45° field of view.
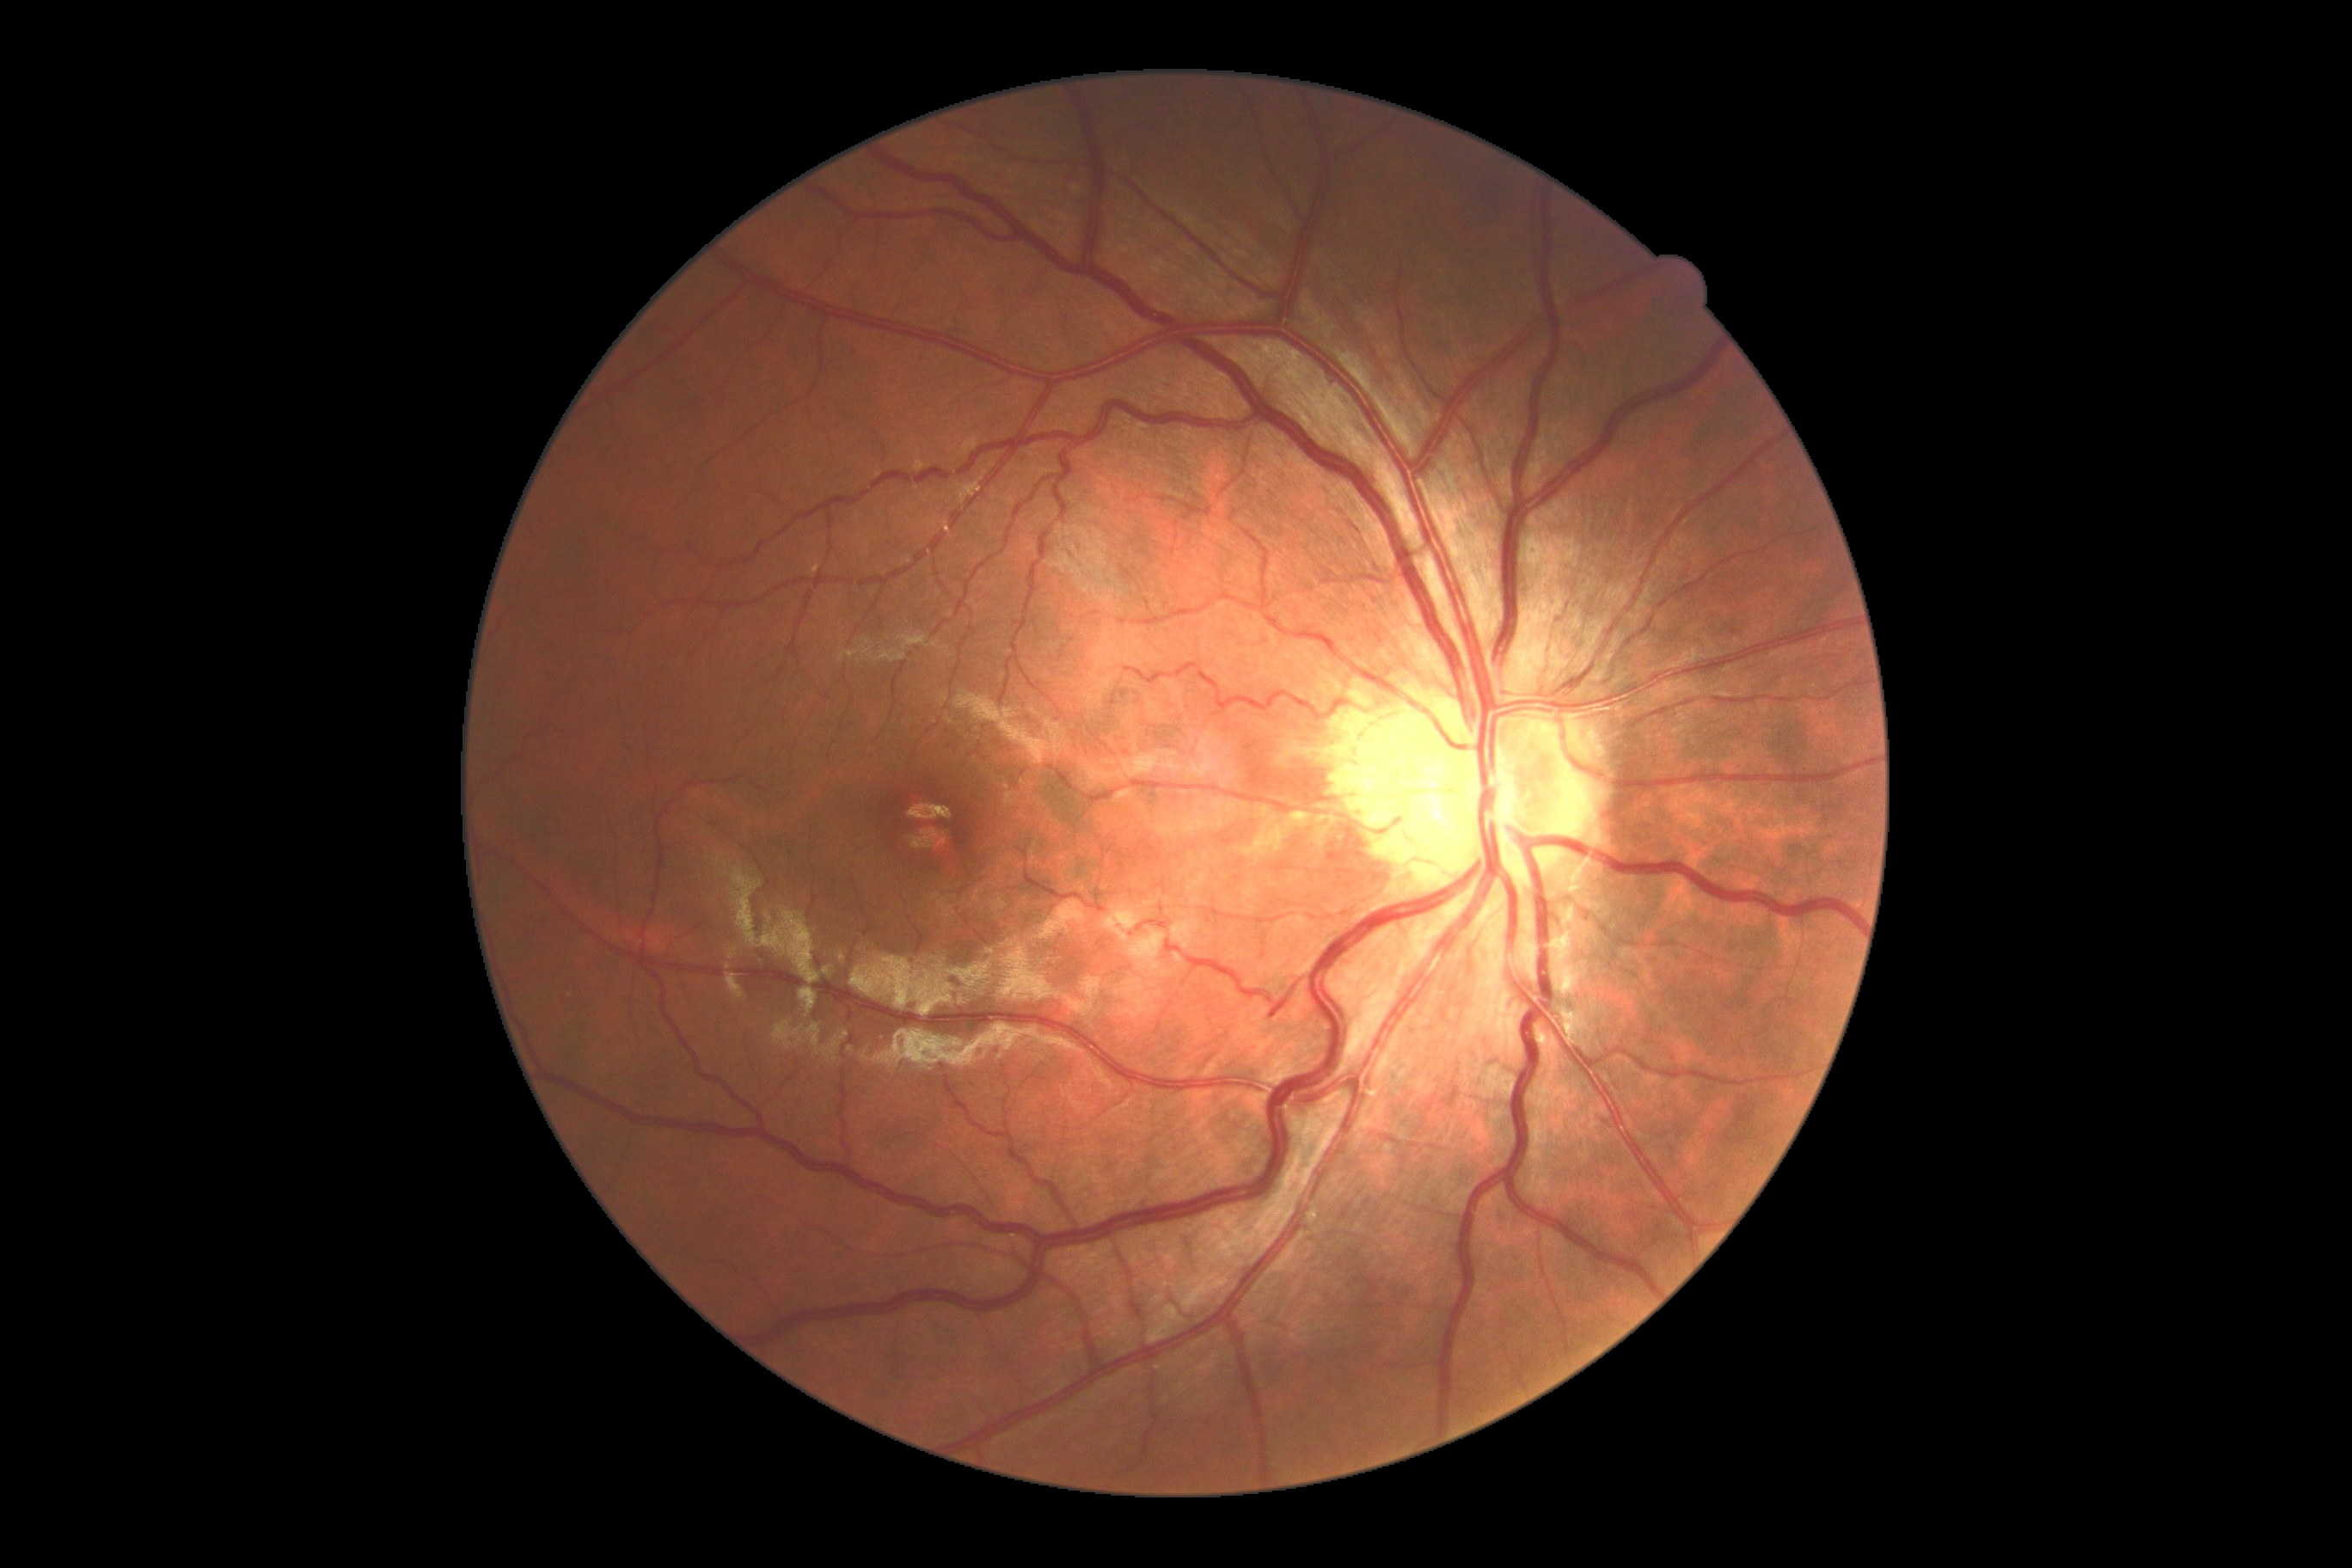 Retinopathy grade is 0. No apparent diabetic retinopathy.